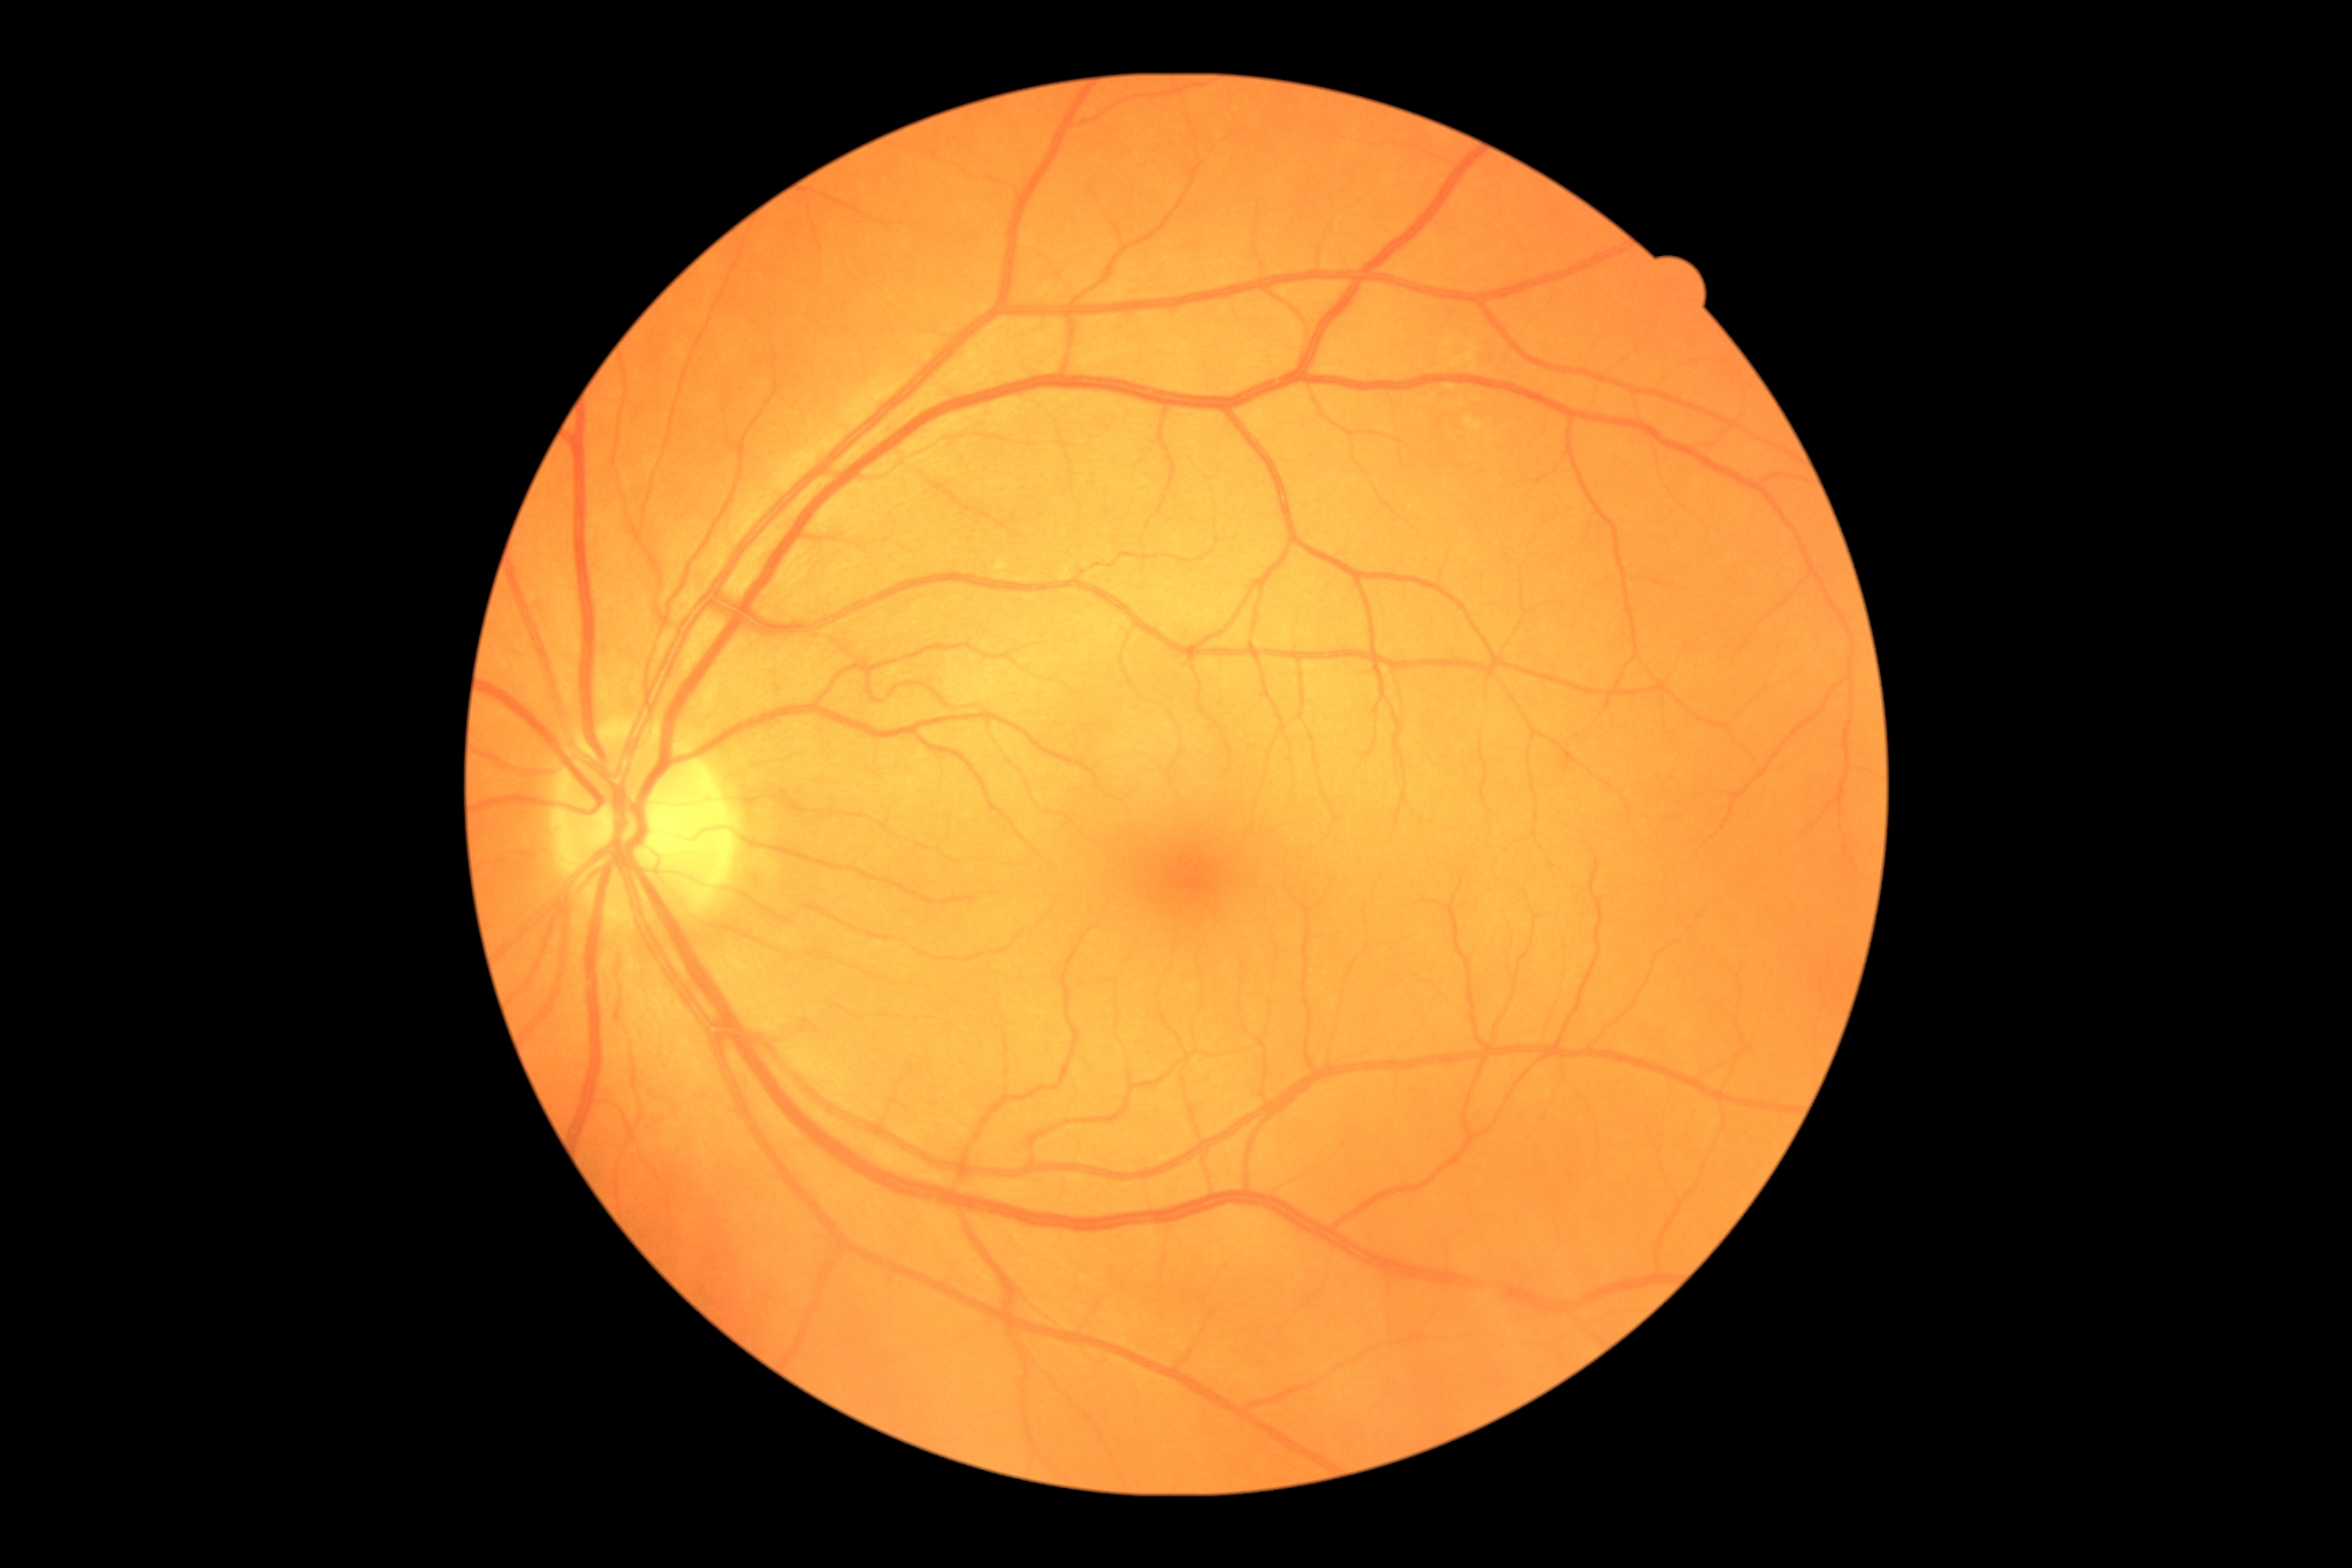

Diabetic retinopathy: 0.